Posterior pole photograph:
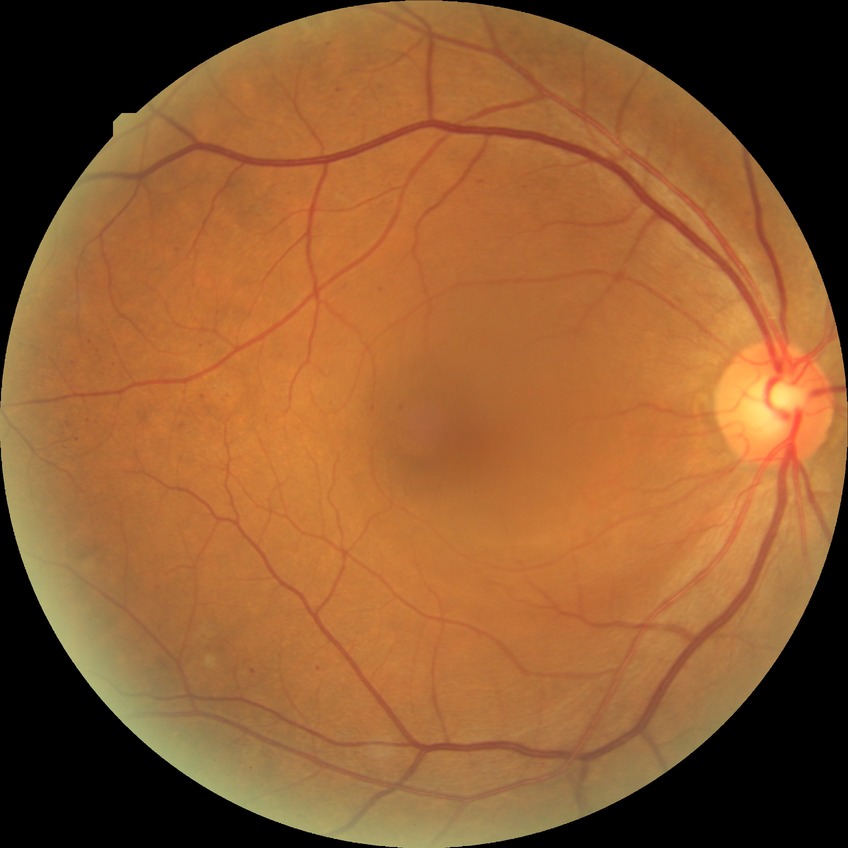

DR class=non-proliferative diabetic retinopathy; diabetic retinopathy (DR)=SDR (simple diabetic retinopathy).